Wide-field fundus image from infant ROP screening; Phoenix ICON, 100° FOV — 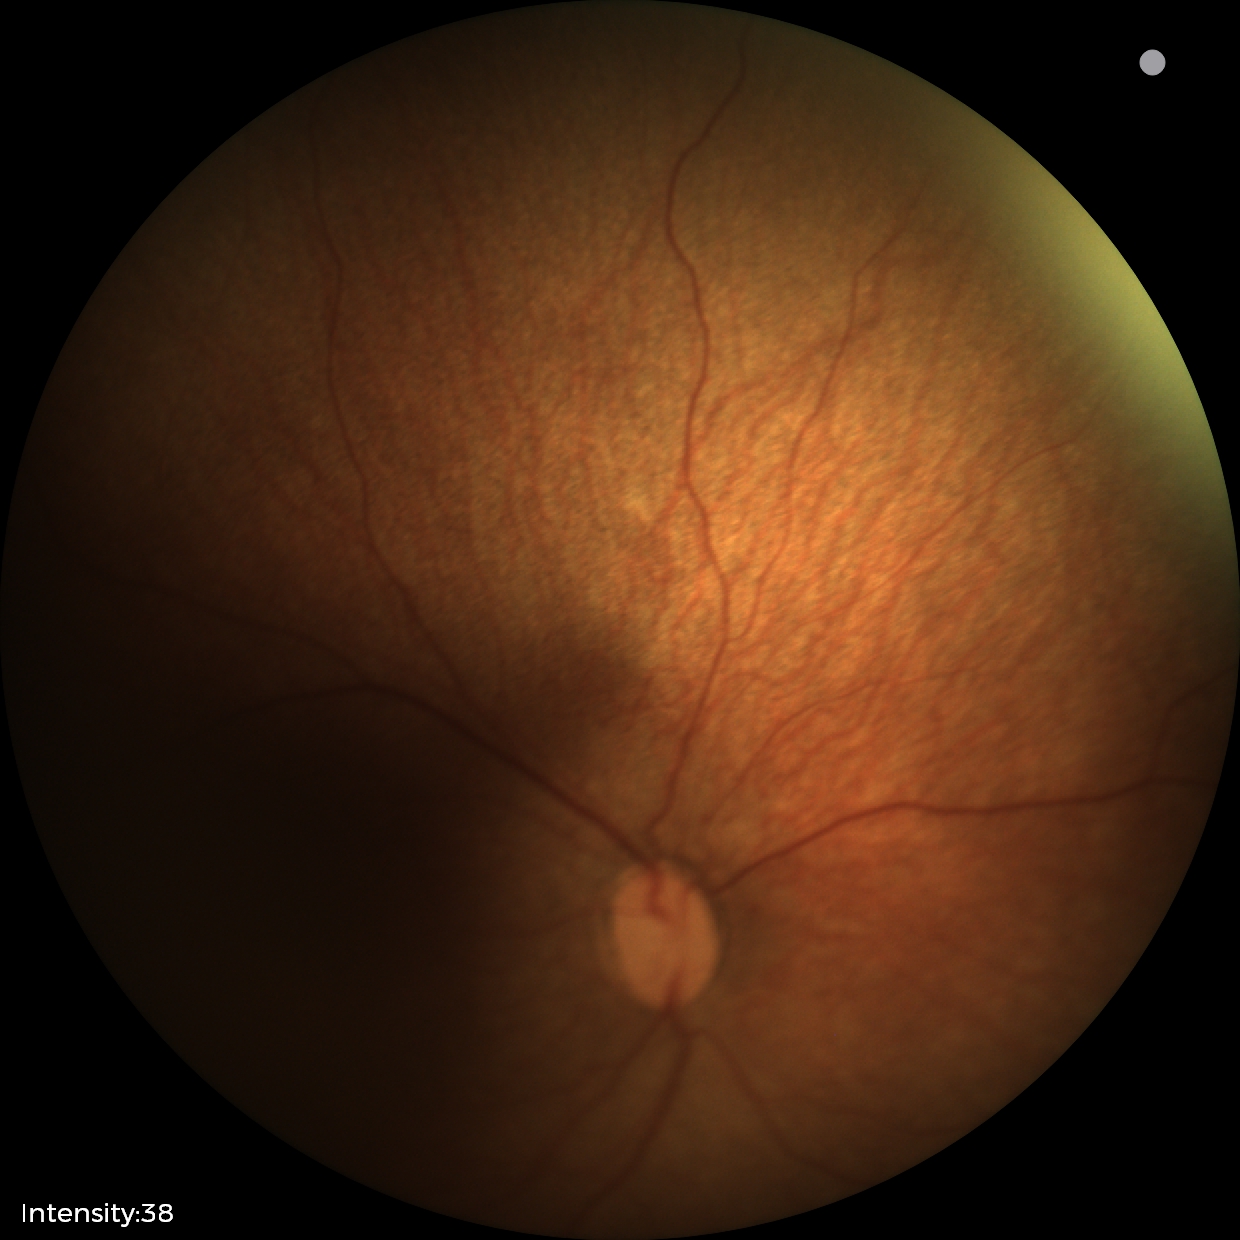

Without plus disease.
Diagnosis from this screening exam: status post retinopathy of prematurity (ROP).